Camera: Natus RetCam Envision (130° FOV); RetCam wide-field infant fundus image; 1440 by 1080 pixels: 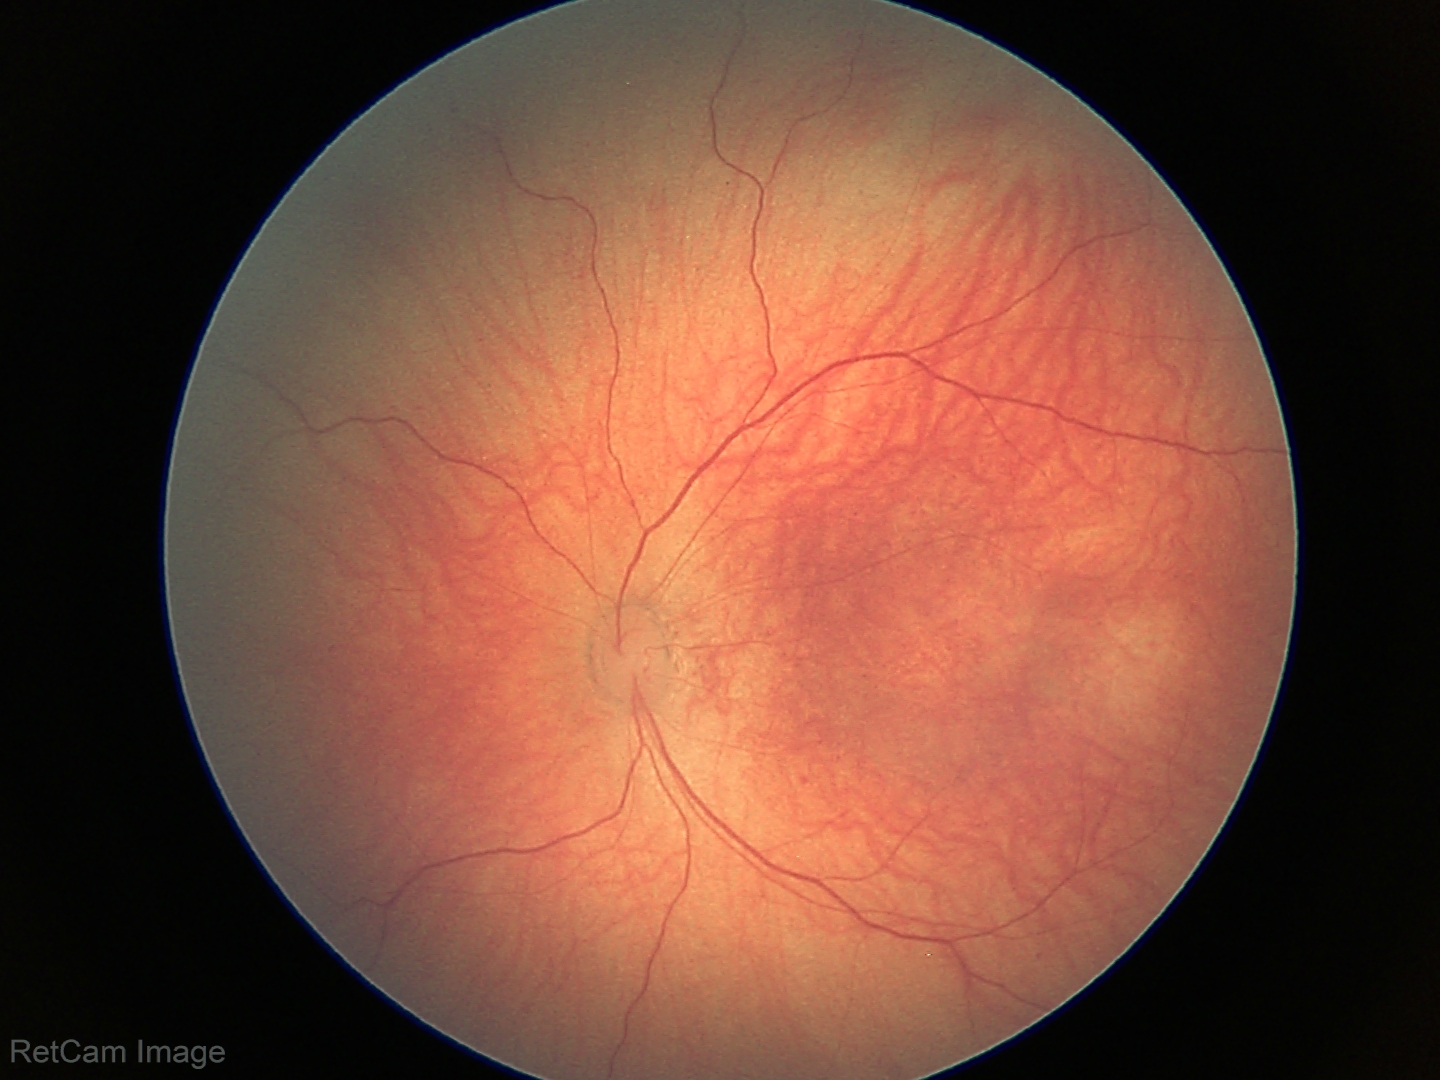
Screening: physiological appearance with no retinal pathology.